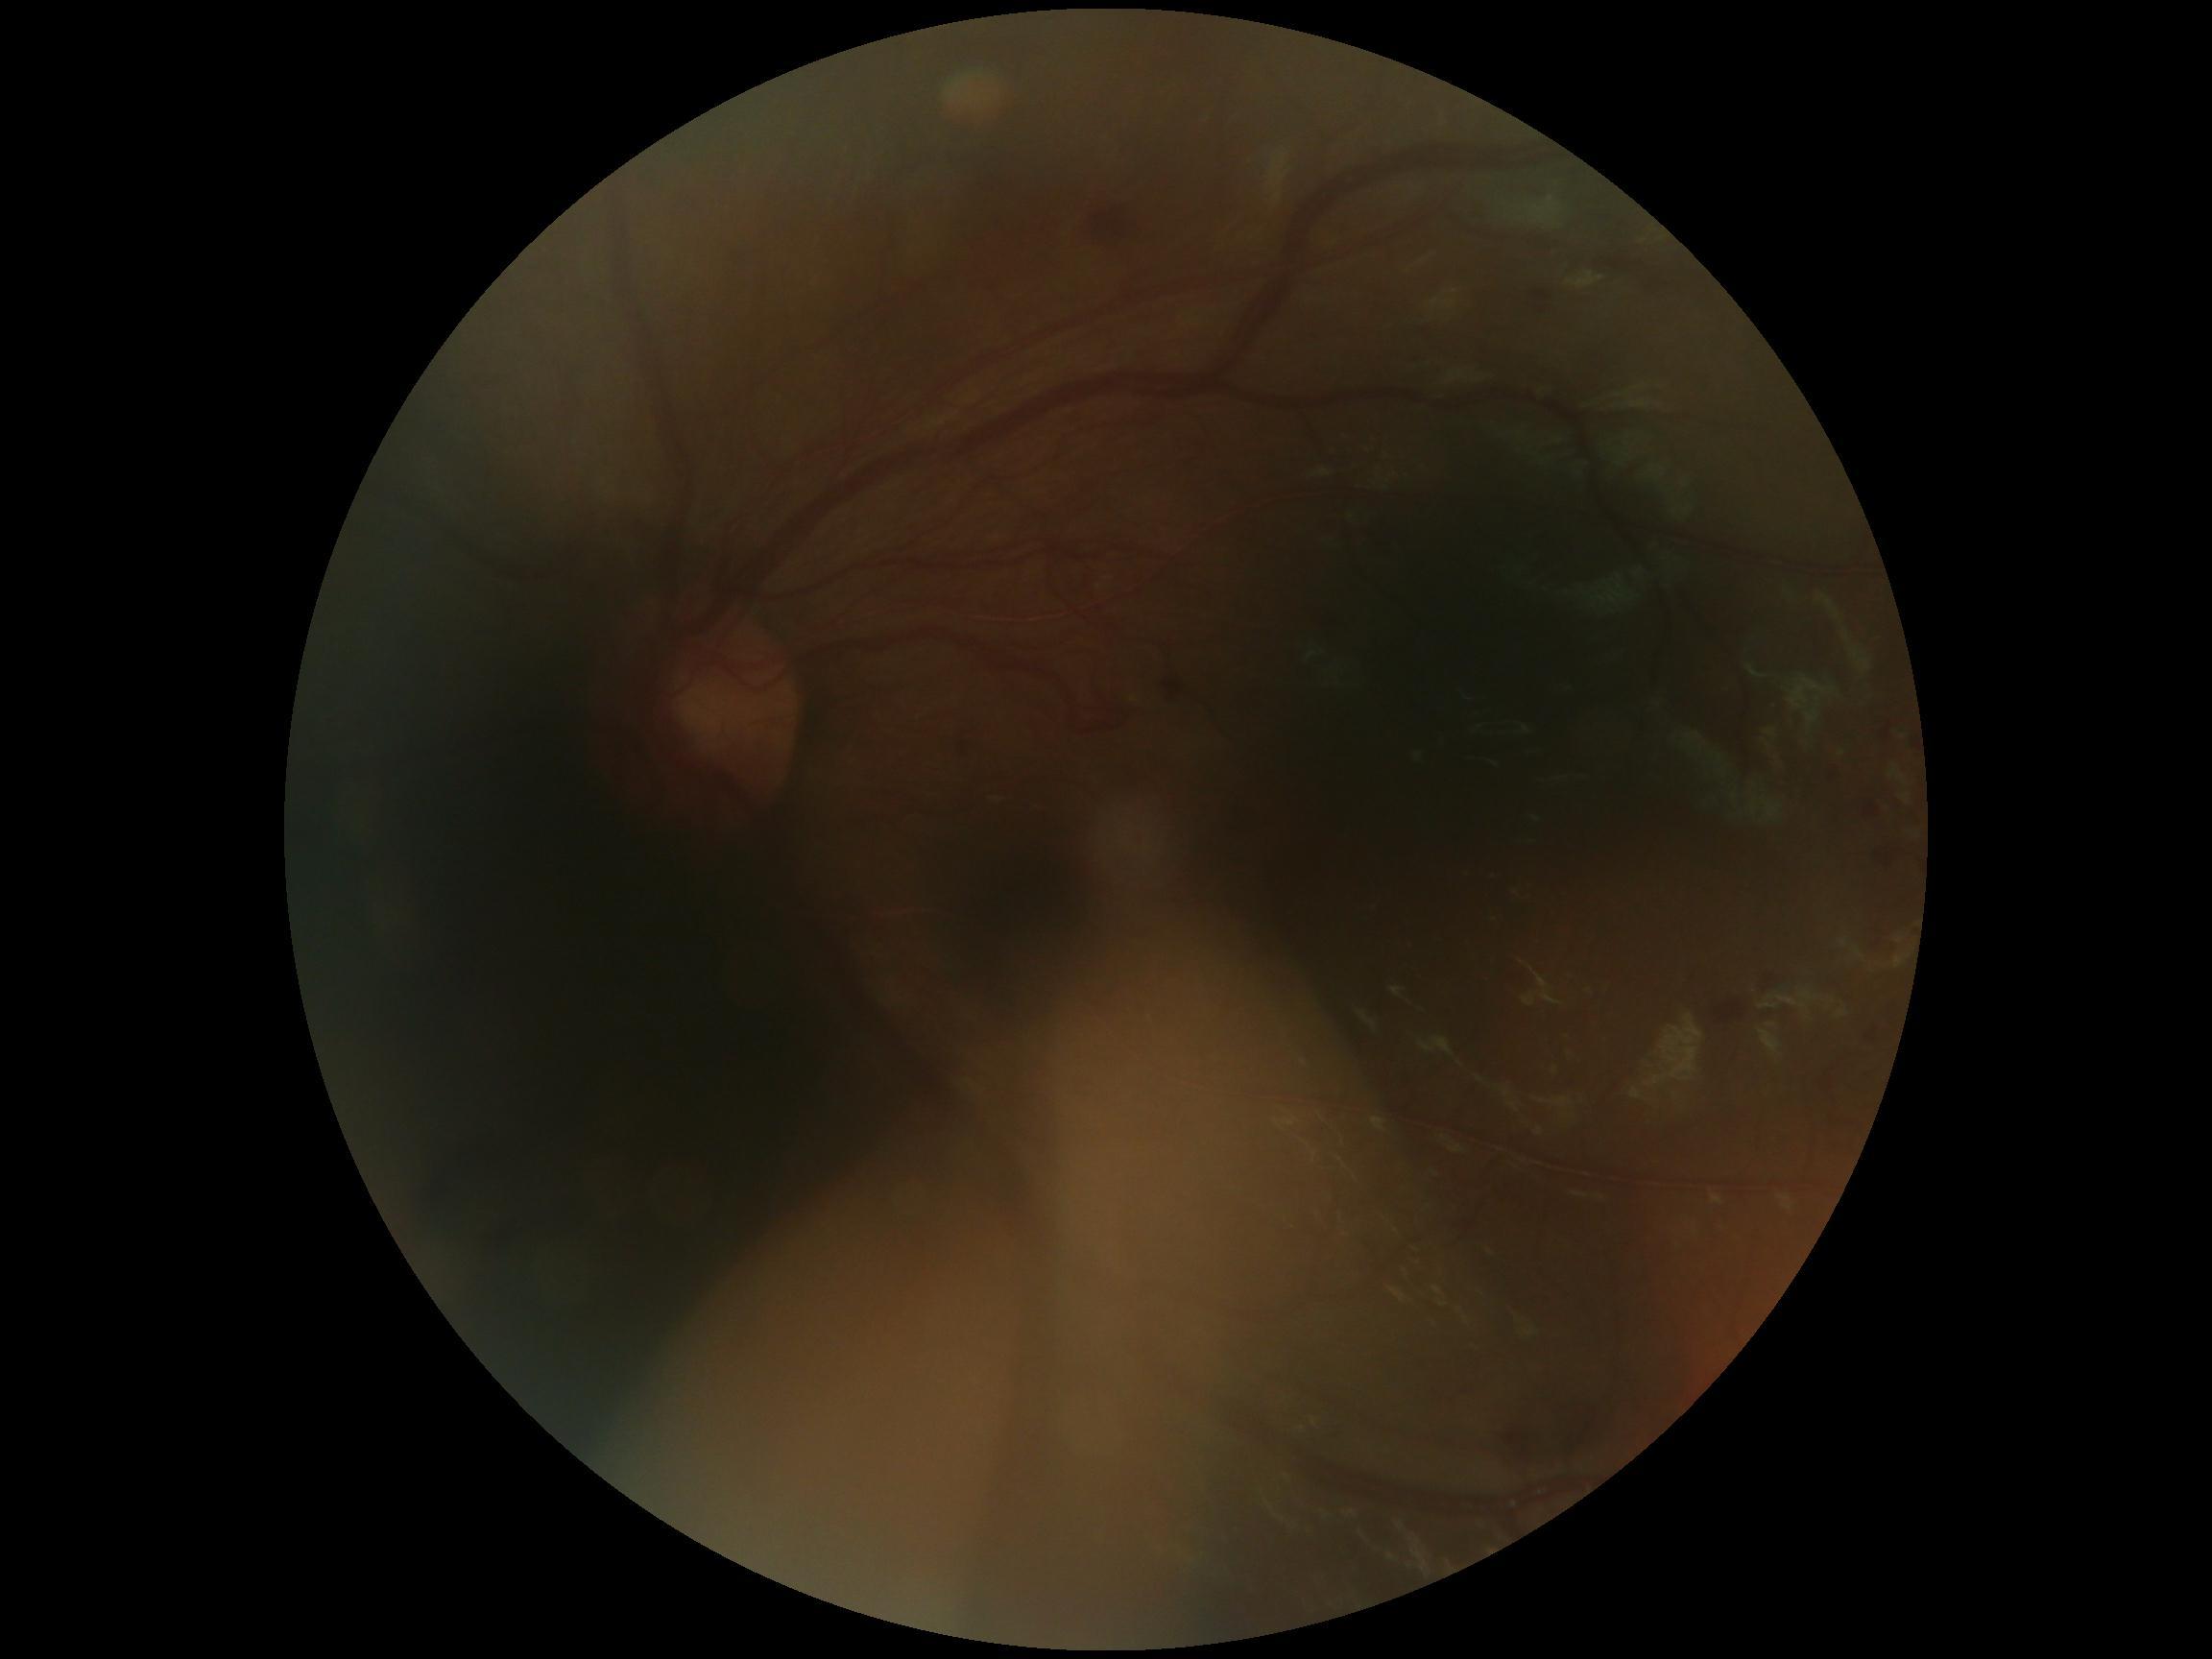

DR grade is 4.